Acquired on the Clarity RetCam 3; pediatric wide-field fundus photograph:
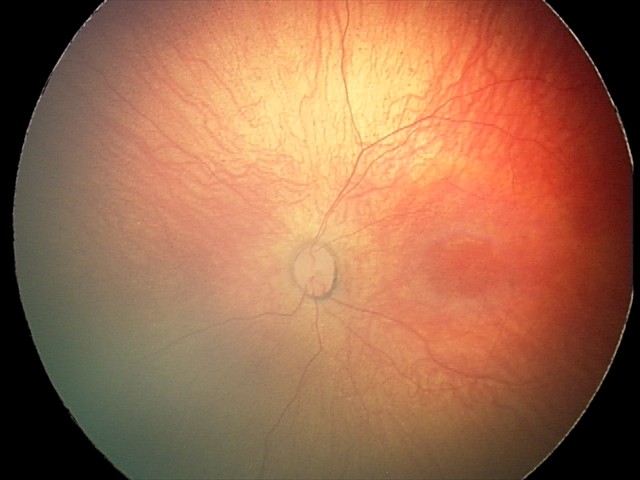
Examination with physiological retinal findings.